Retinal fundus photograph:
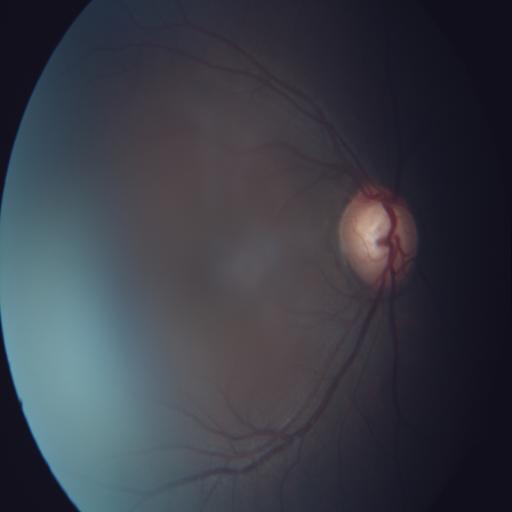 The image shows MH (media haze) & ODC (optic disc cupping).